Infant wide-field fundus photograph: 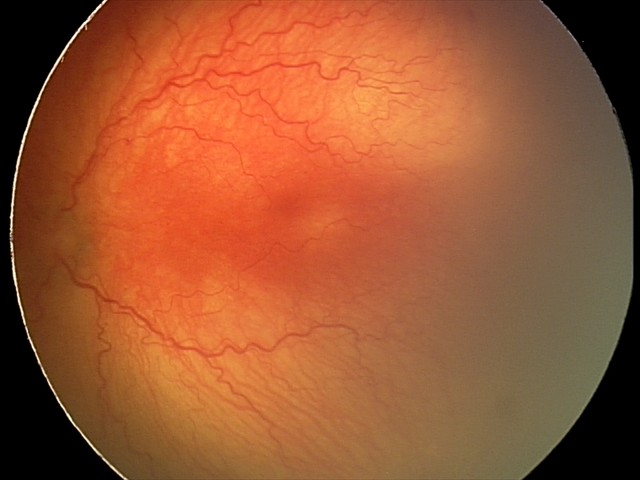
Examination diagnosed as aggressive retinopathy of prematurity — rapidly progressive severe ROP with prominent plus disease, often without classic stage progression. With plus disease.